1932x1932px · retinal fundus photograph: 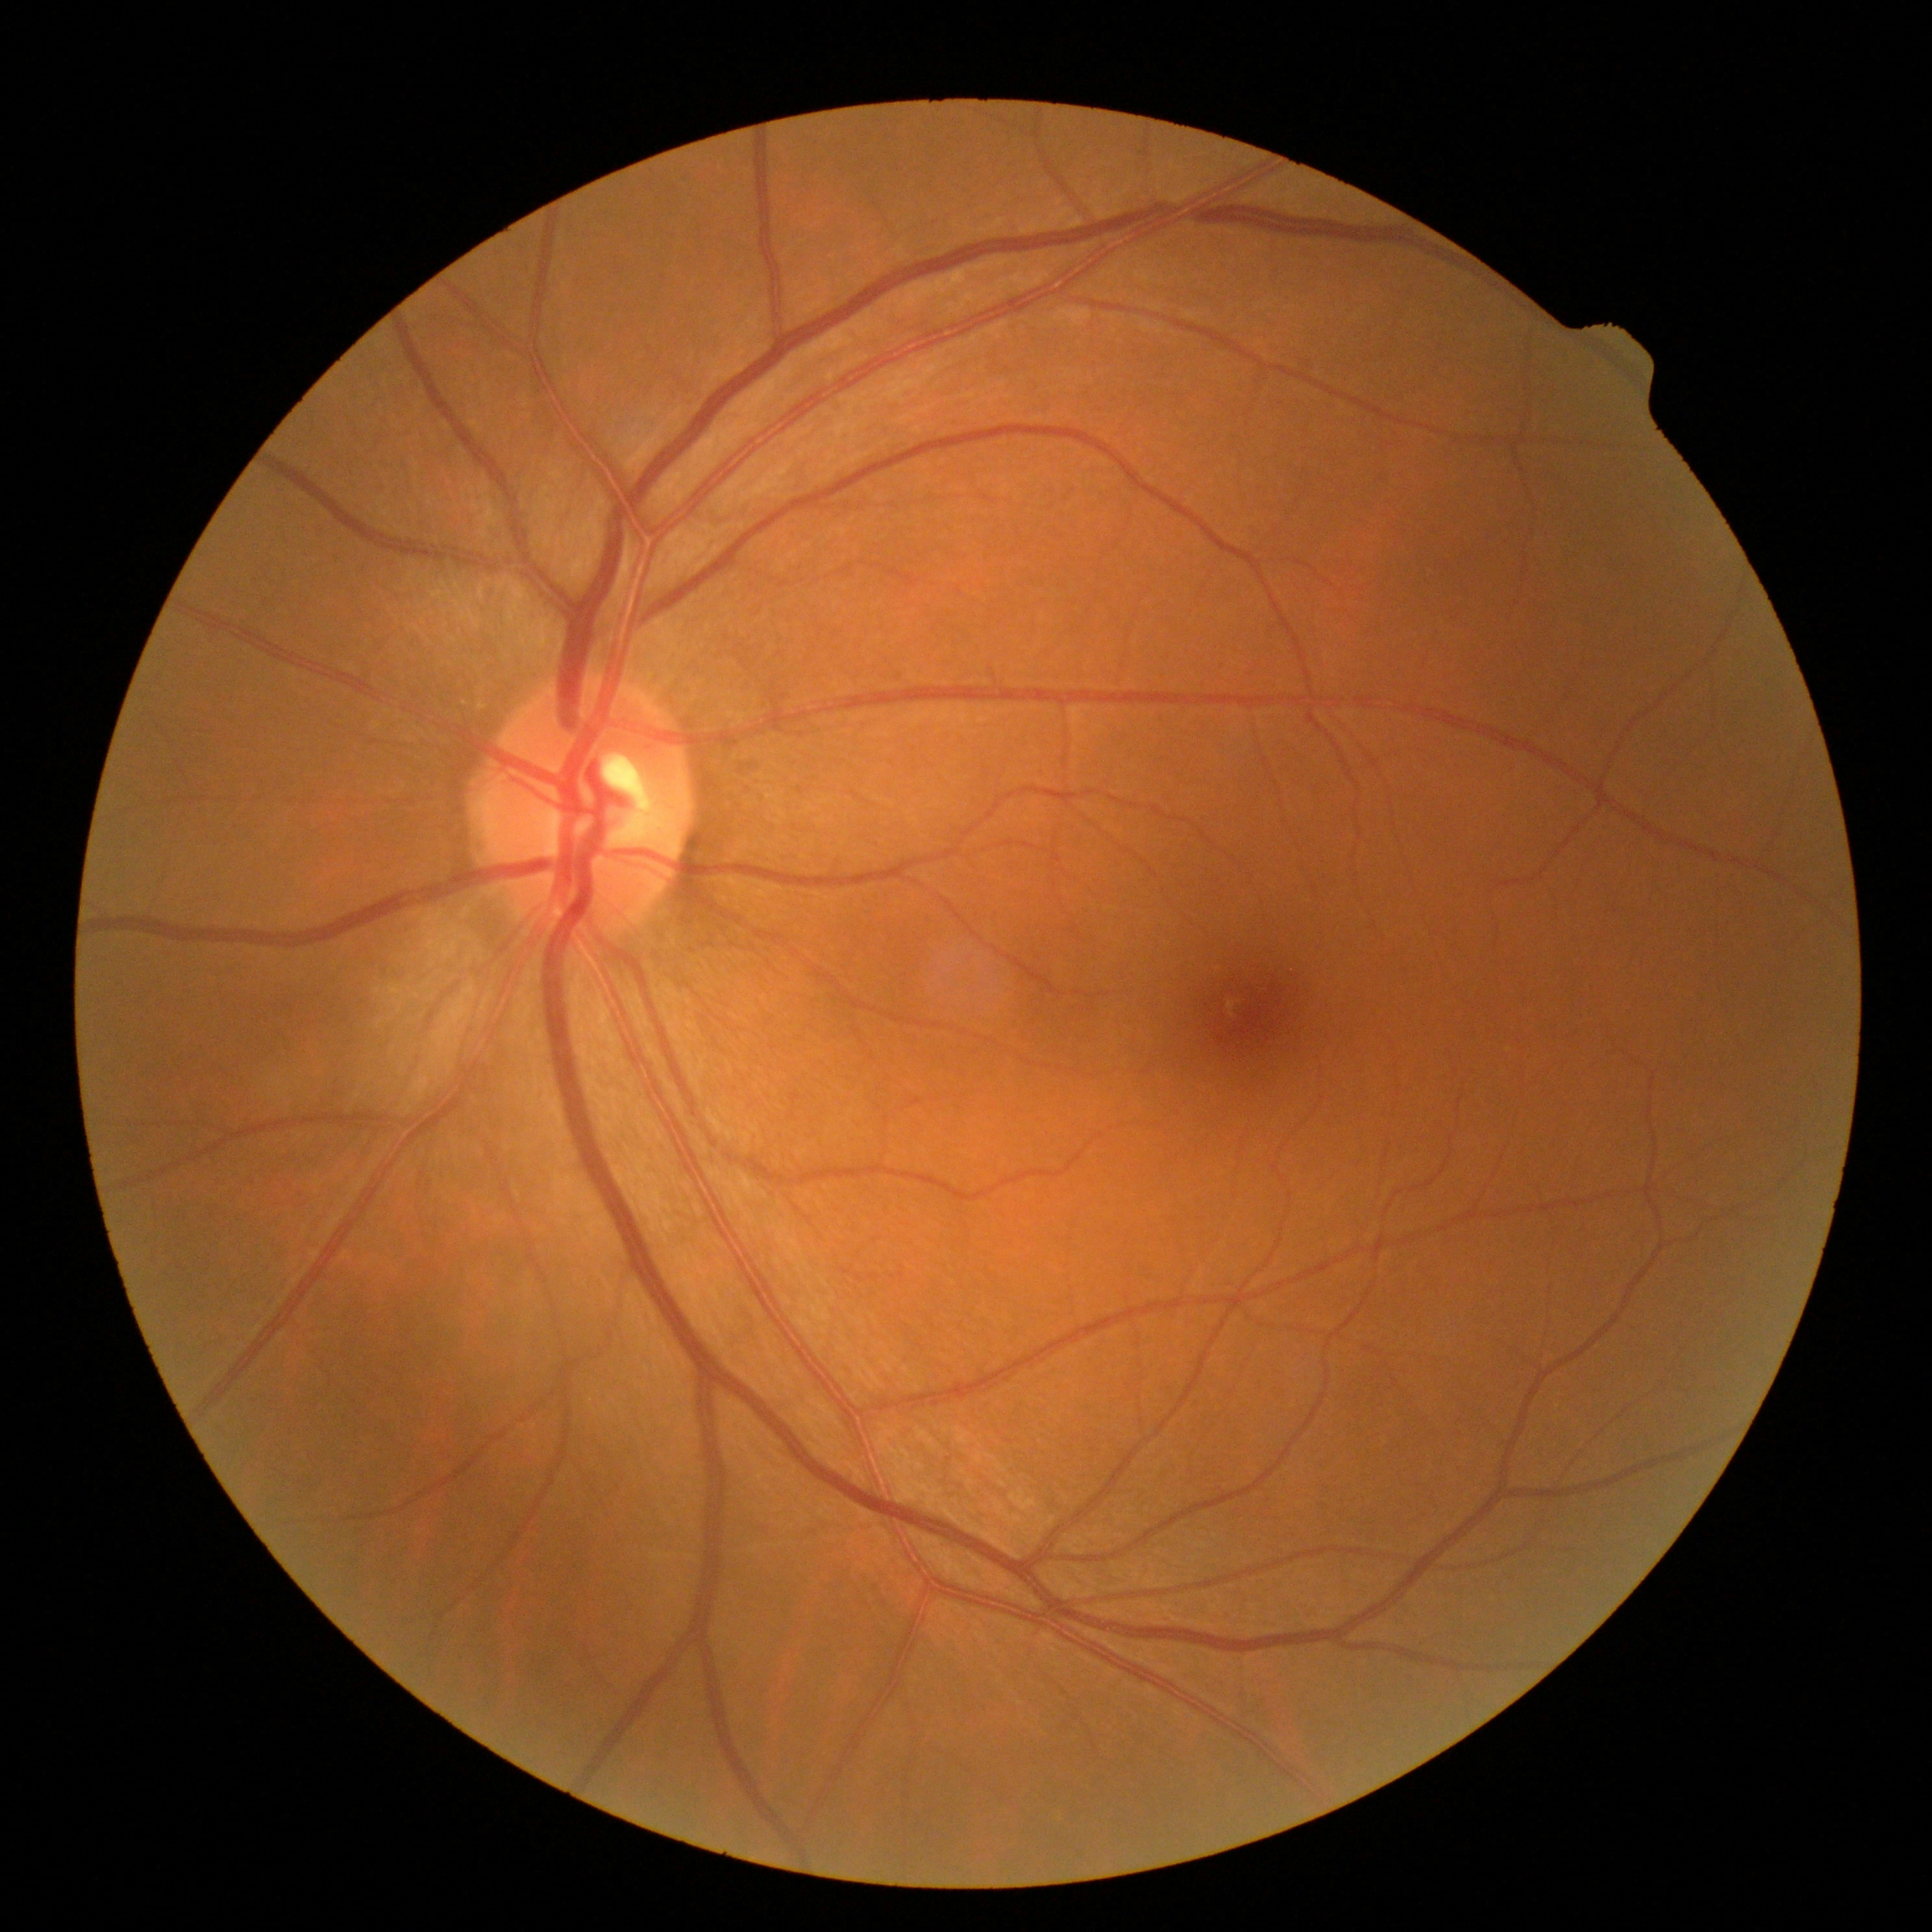

No diabetic retinal disease findings. Retinopathy: grade 0 (no apparent retinopathy).